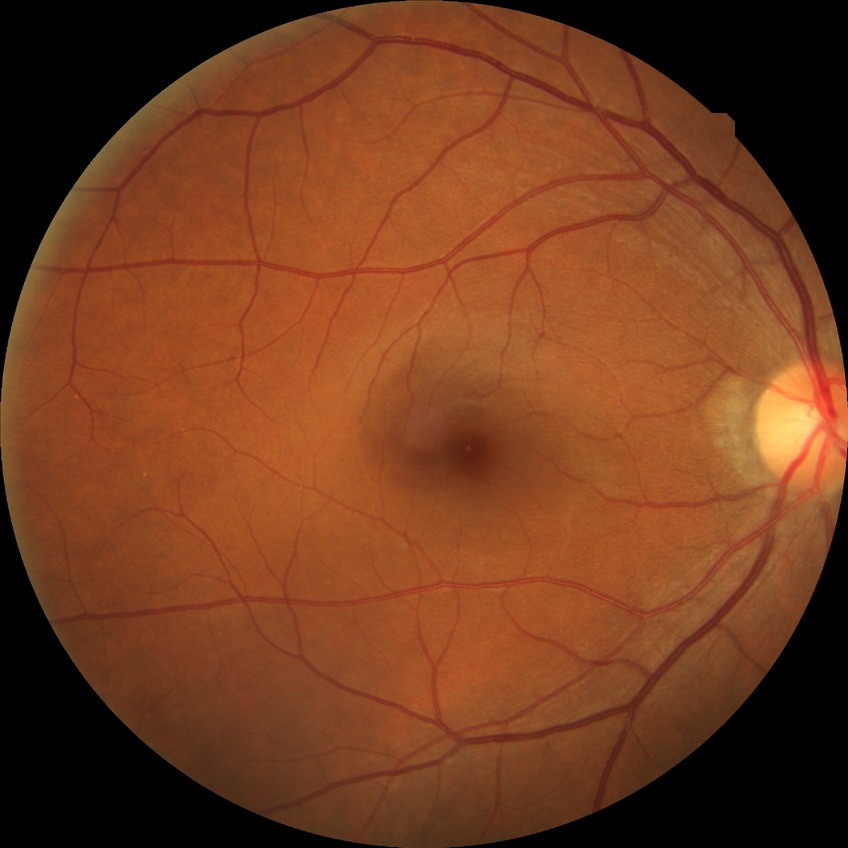
diabetic retinopathy stage: no diabetic retinopathy.